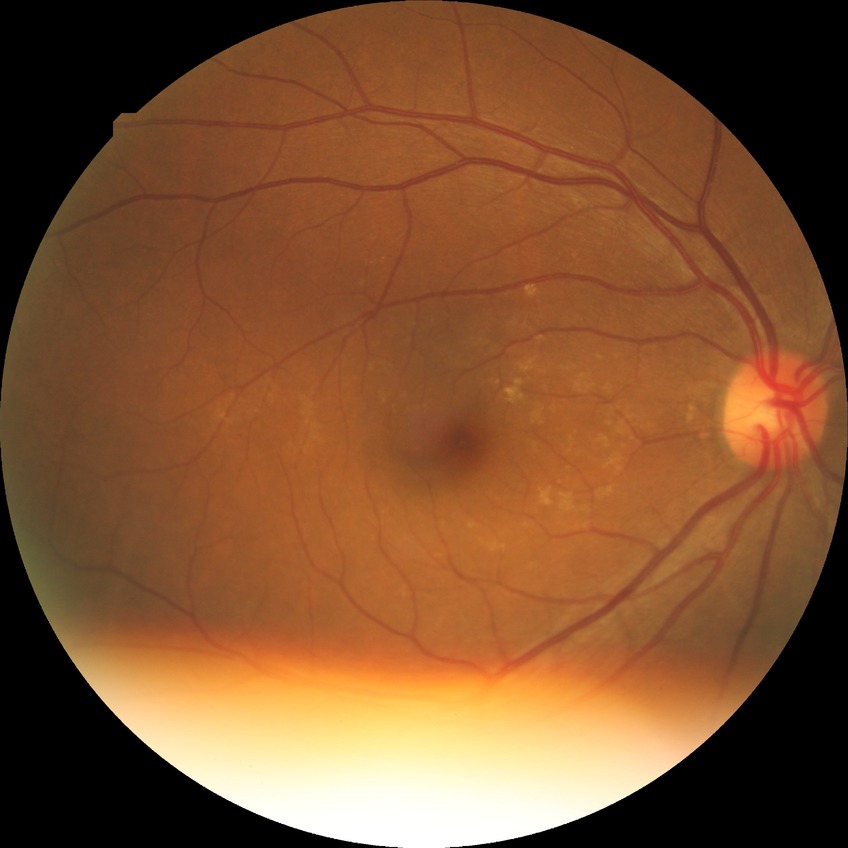
Davis grading: no diabetic retinopathy.